Infant wide-field fundus photograph — 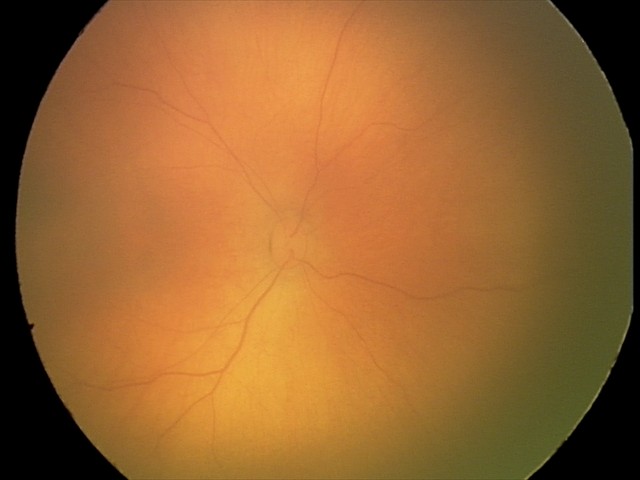
Examination with physiological retinal findings.